2352 by 1568 pixels.
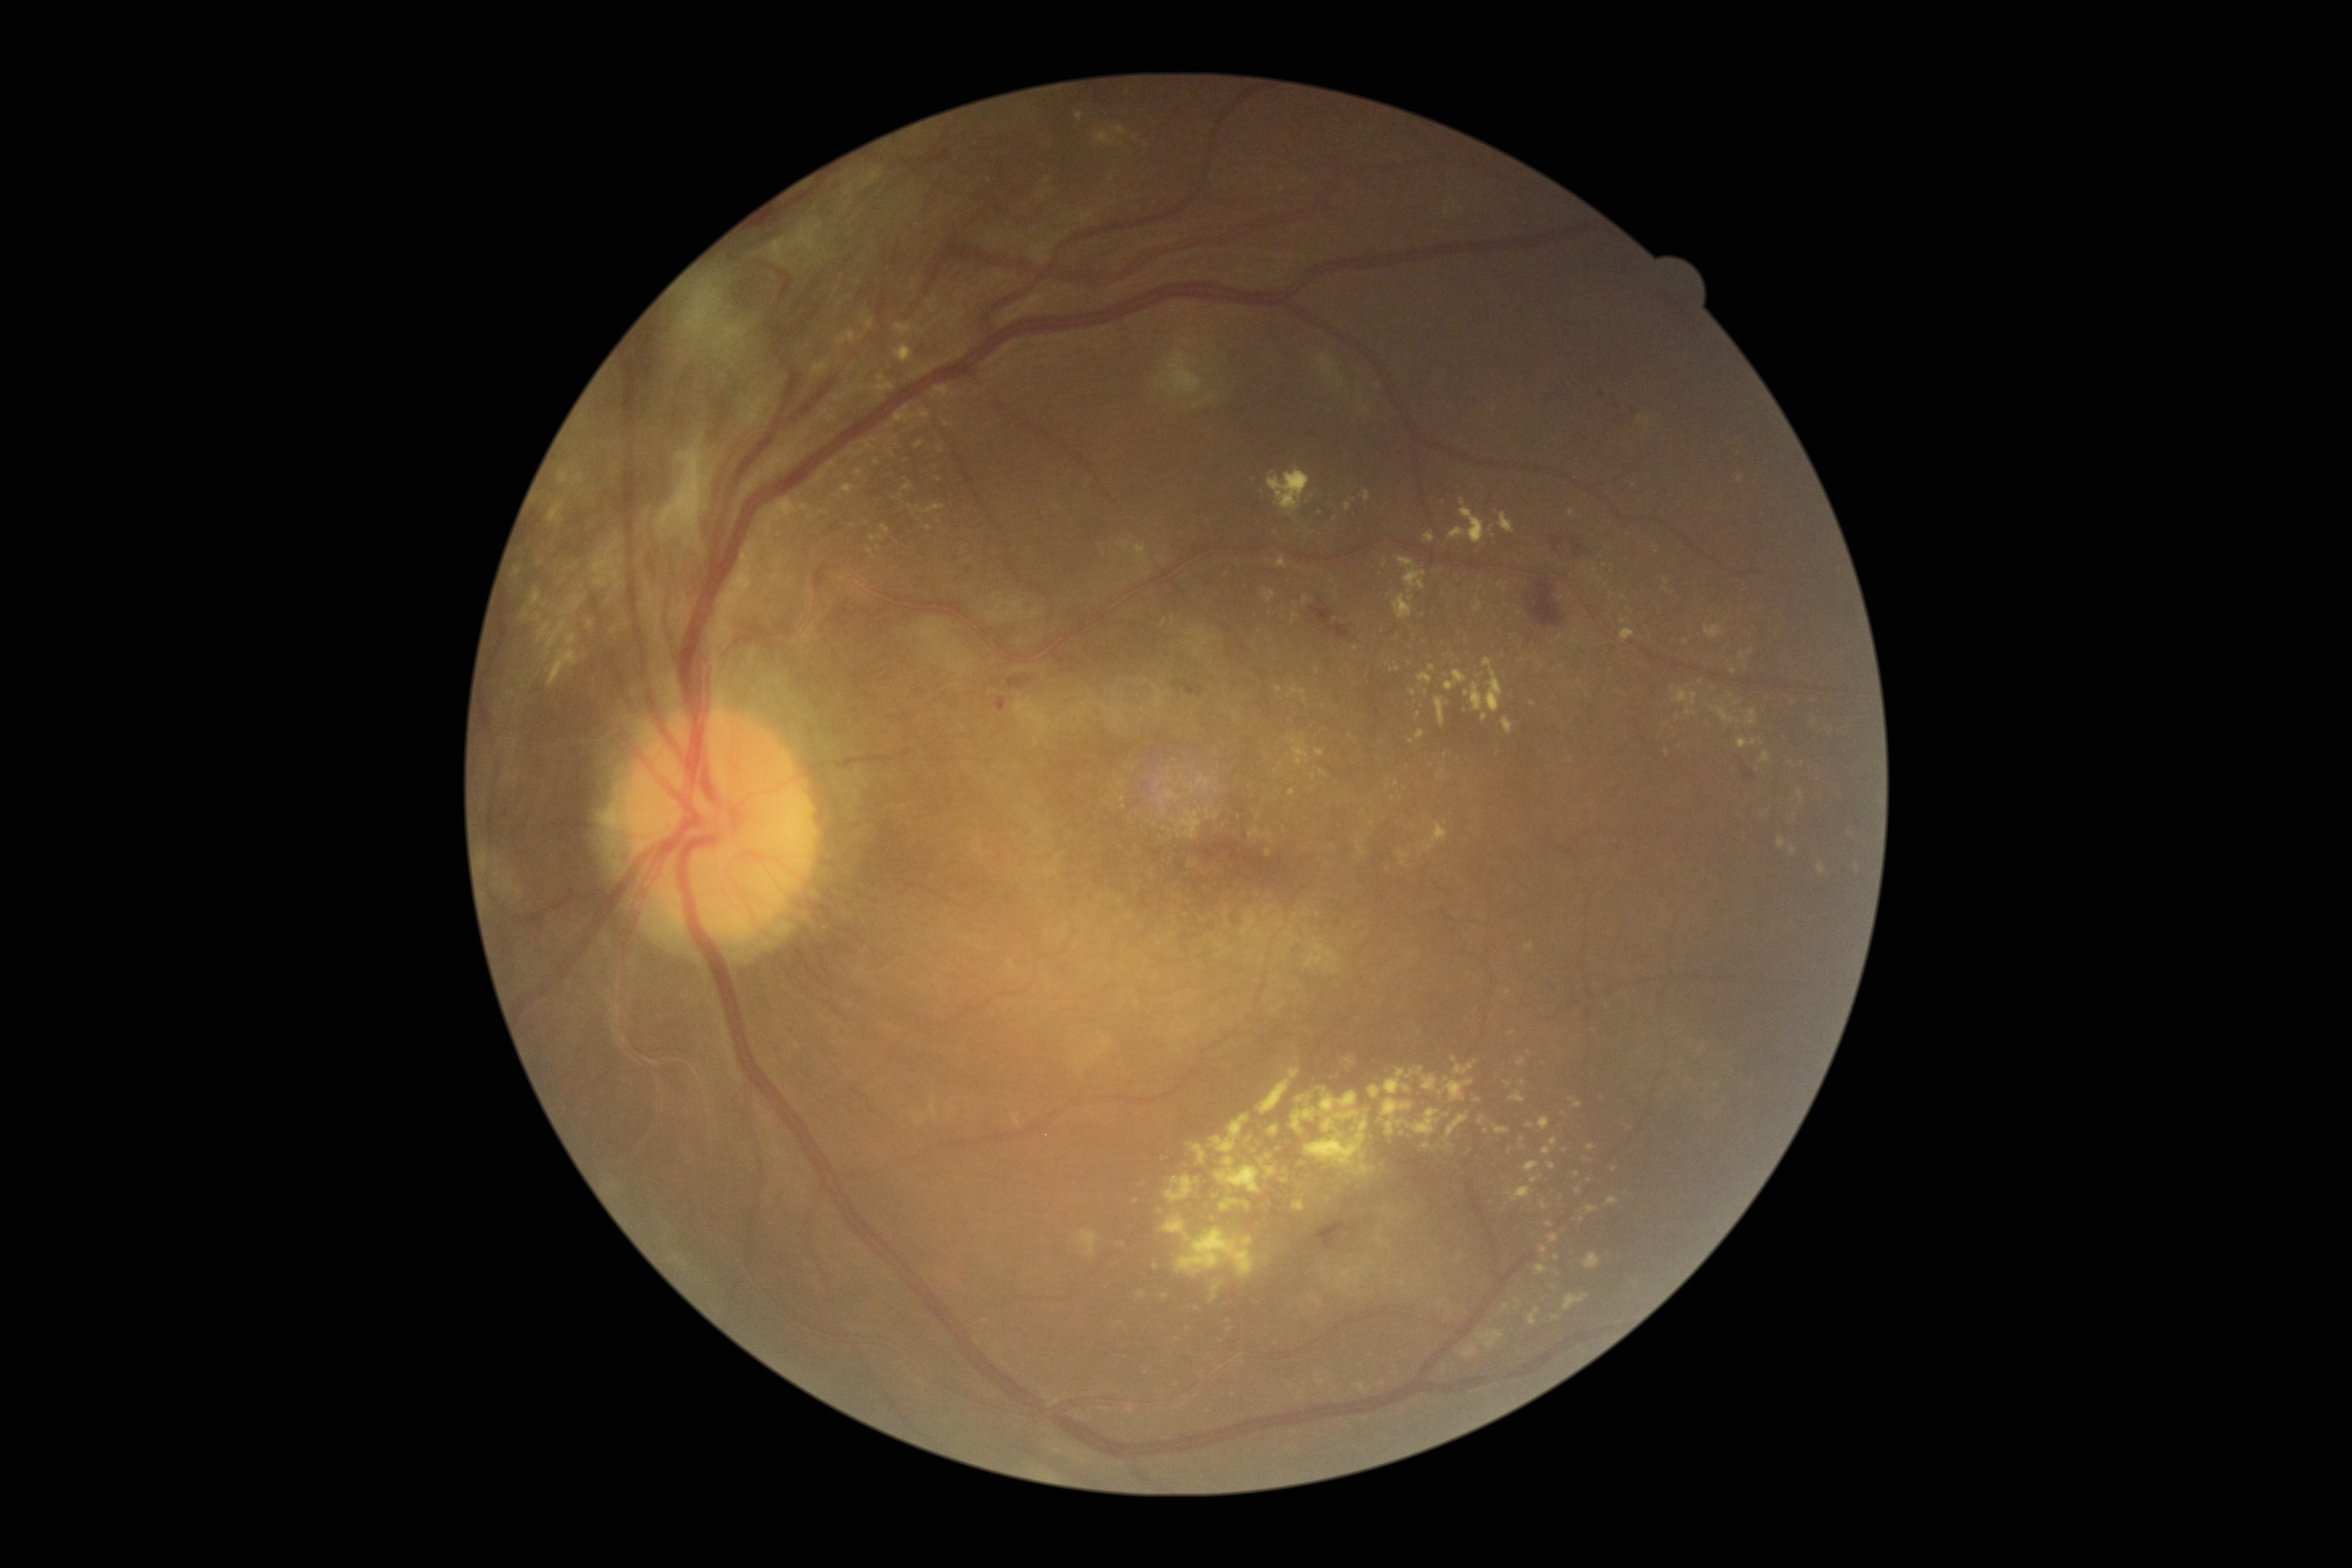 {"partial":true,"dr_grade":4,"dr_grade_name":"PDR","lesions":{"ex":[[1393,593,1413,619],[1417,1067,1423,1075],[570,595,585,610],[1295,1093,1312,1103],[1817,862,1826,875],[1256,1069,1300,1115],[1670,685,1698,716],[1797,789,1803,802],[916,503,946,514],[1310,1295,1322,1304],[560,609,567,618]],"ex_small_centers":[[1744,667],[1549,1224],[1447,1114],[1123,1245],[1734,671],[1447,1078],[946,424],[1254,1150]]}}